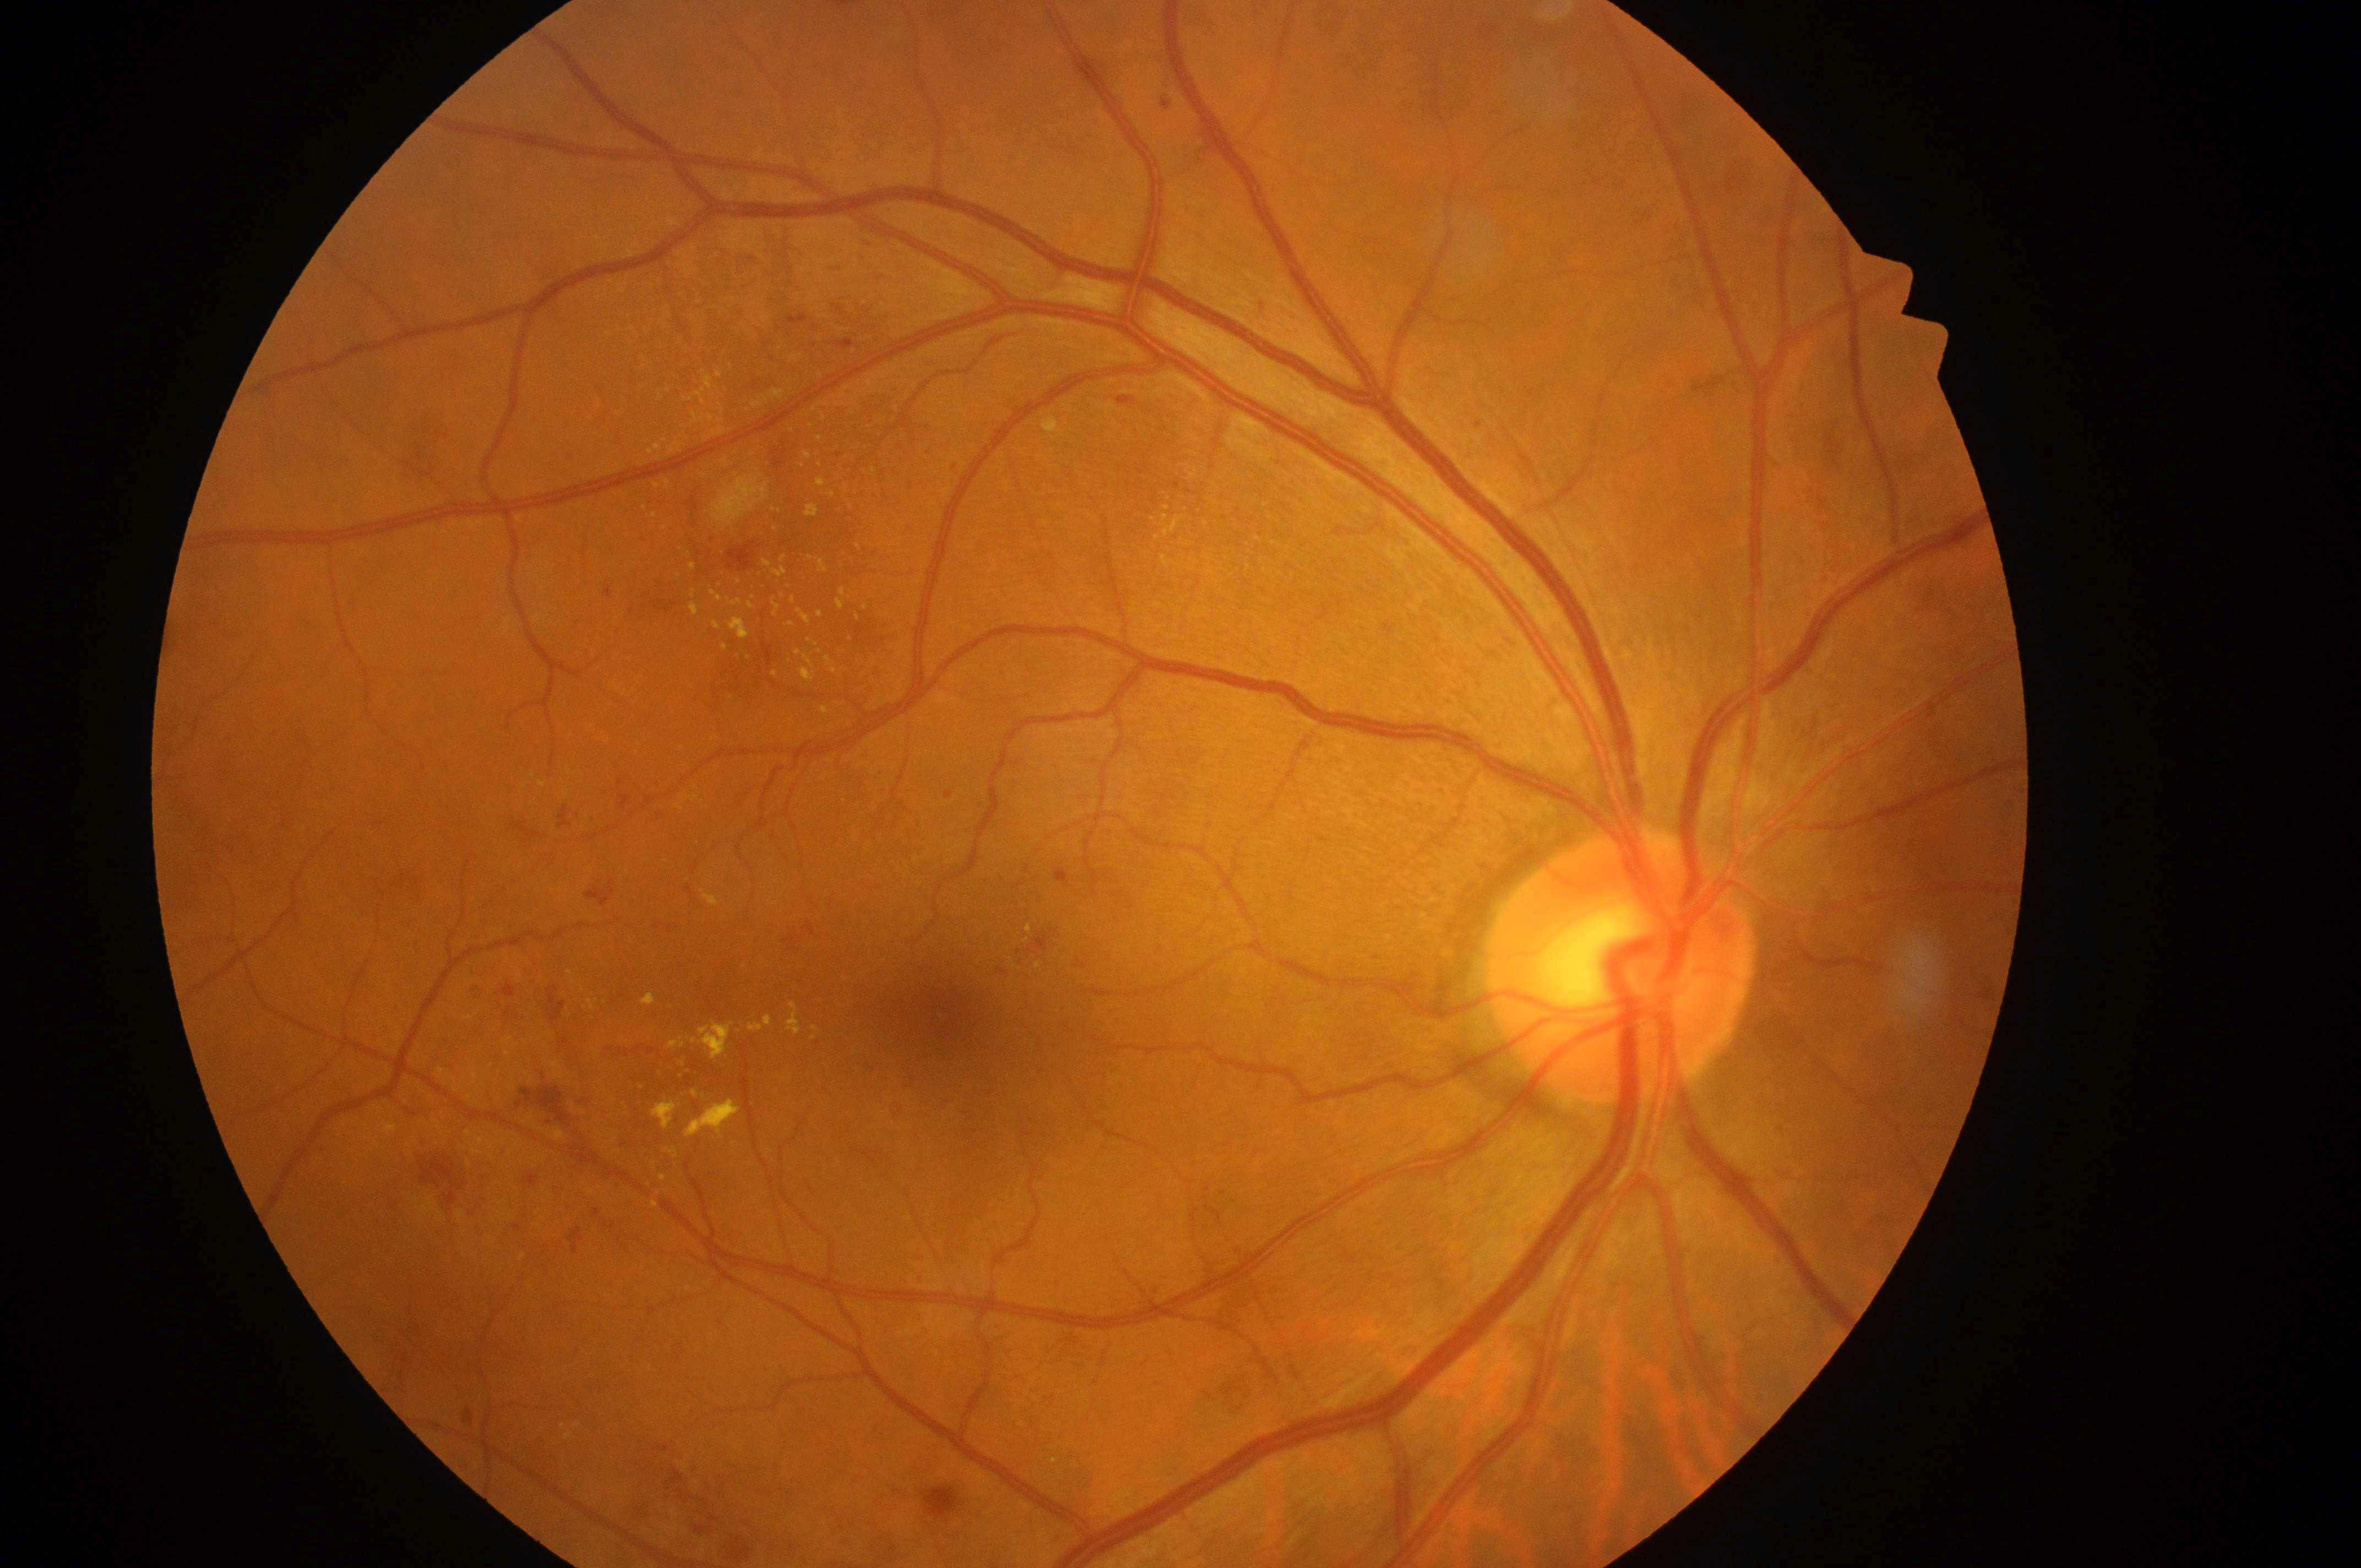
DR class: non-proliferative diabetic retinopathy. Diabetic macular edema (DME): grade 2 (high risk). The image shows the right eye. Diabetic retinopathy (DR): moderate NPDR (grade 2). Optic disc center: 1615px, 983px. Fovea located at 949px, 1014px.